45-degree field of view, modified Davis classification, 848x848 — 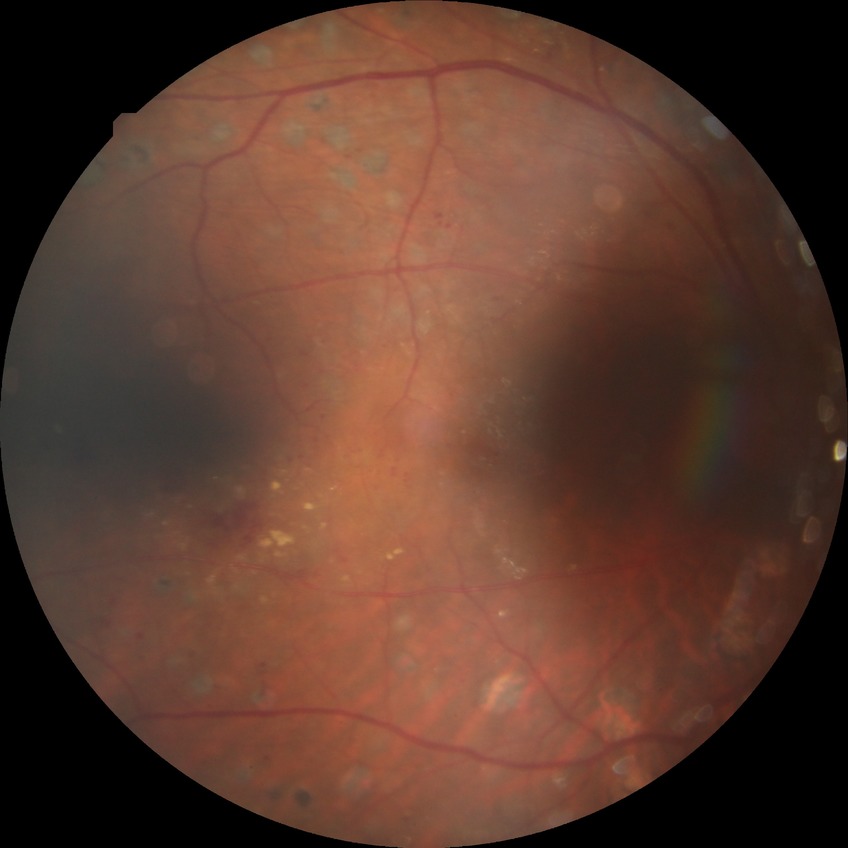 diabetic retinopathy (DR): proliferative diabetic retinopathy (PDR).